Pediatric wide-field fundus photograph · 1240 by 1240 pixels:
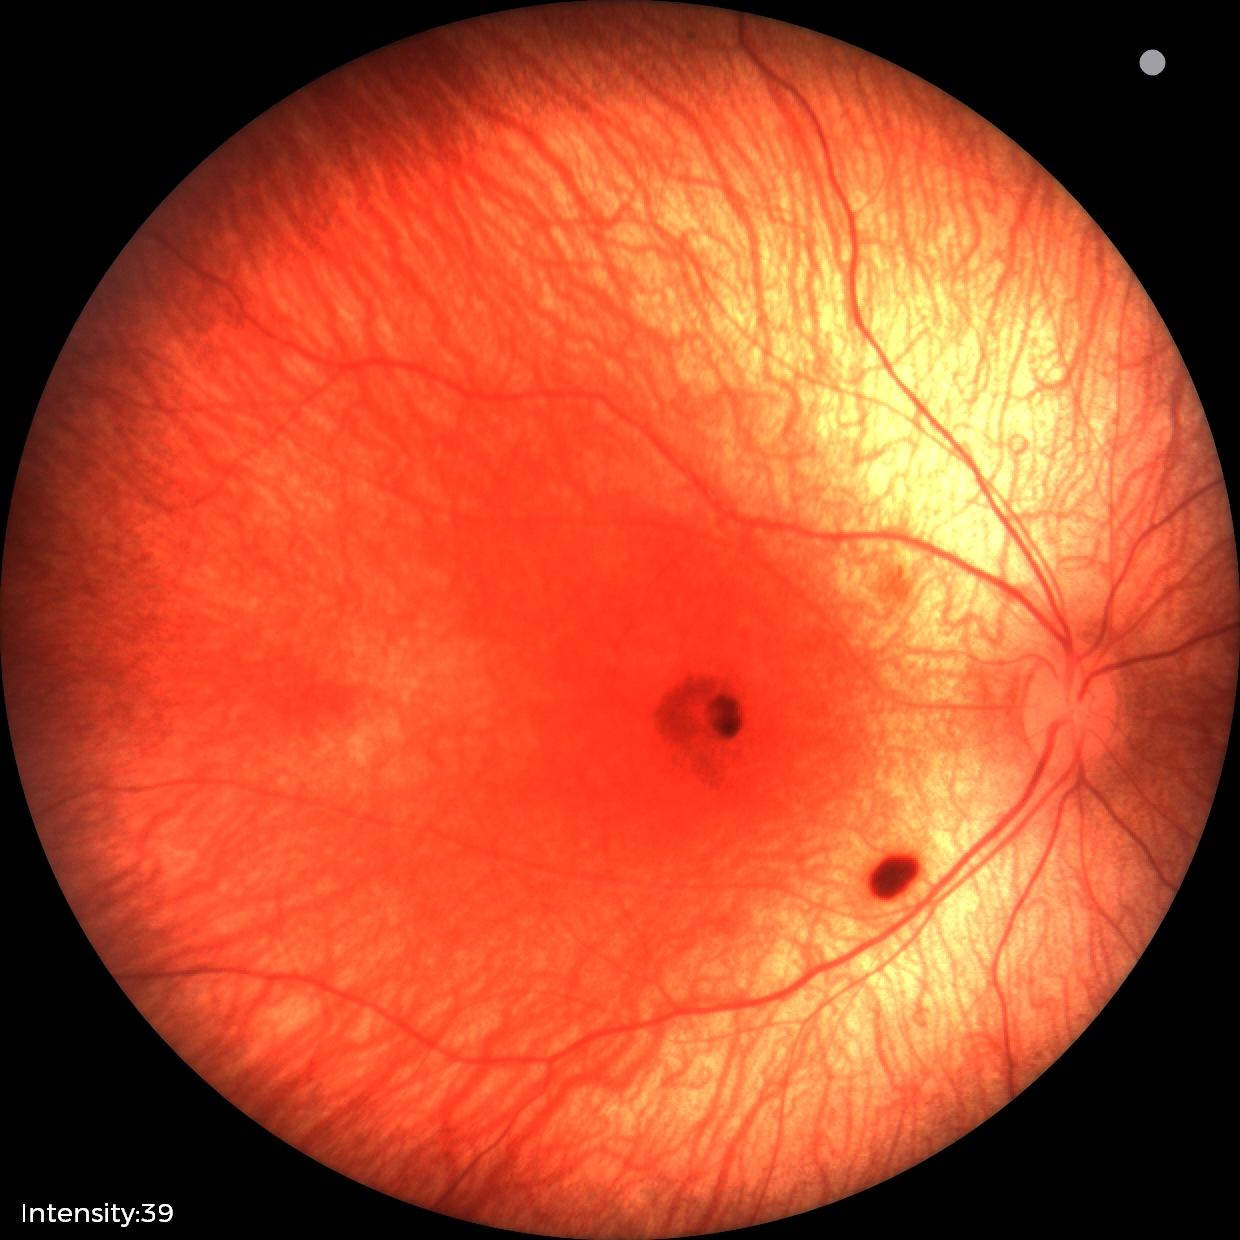
Diagnosis from this screening exam: retinal hemorrhages.